2352x1568px.
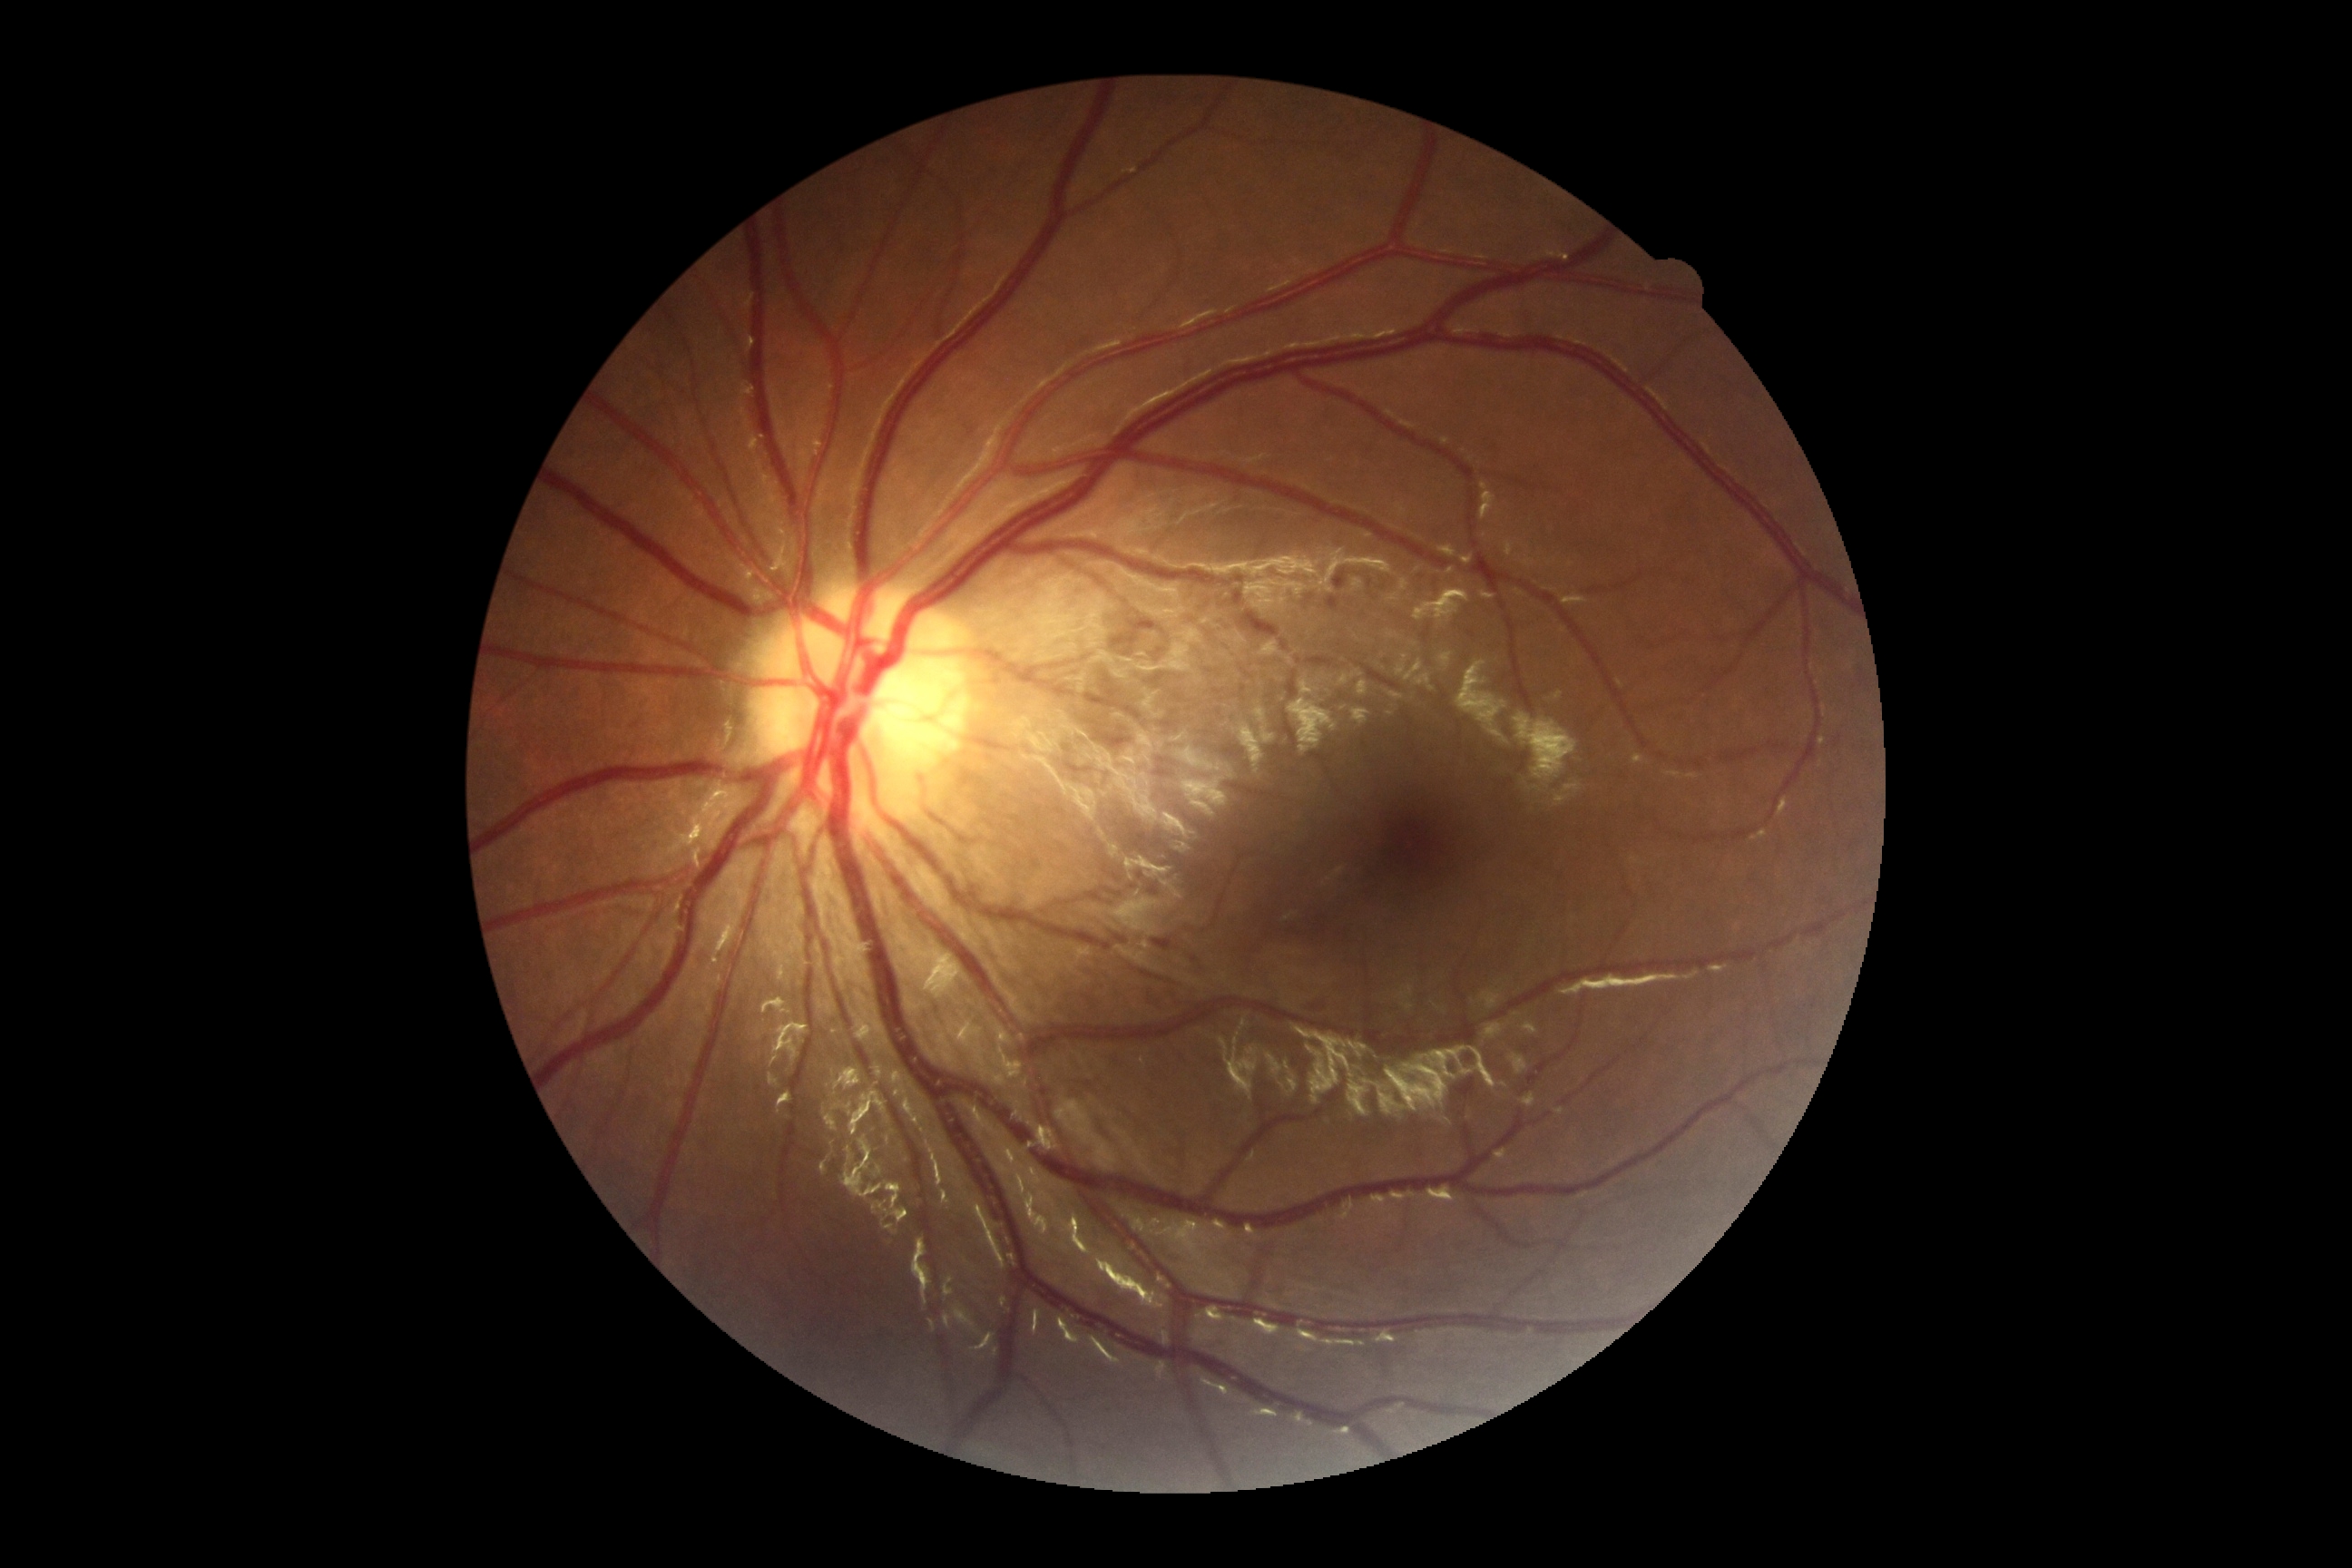   dr_grade: grade 0 (no apparent retinopathy) — no visible signs of diabetic retinopathy